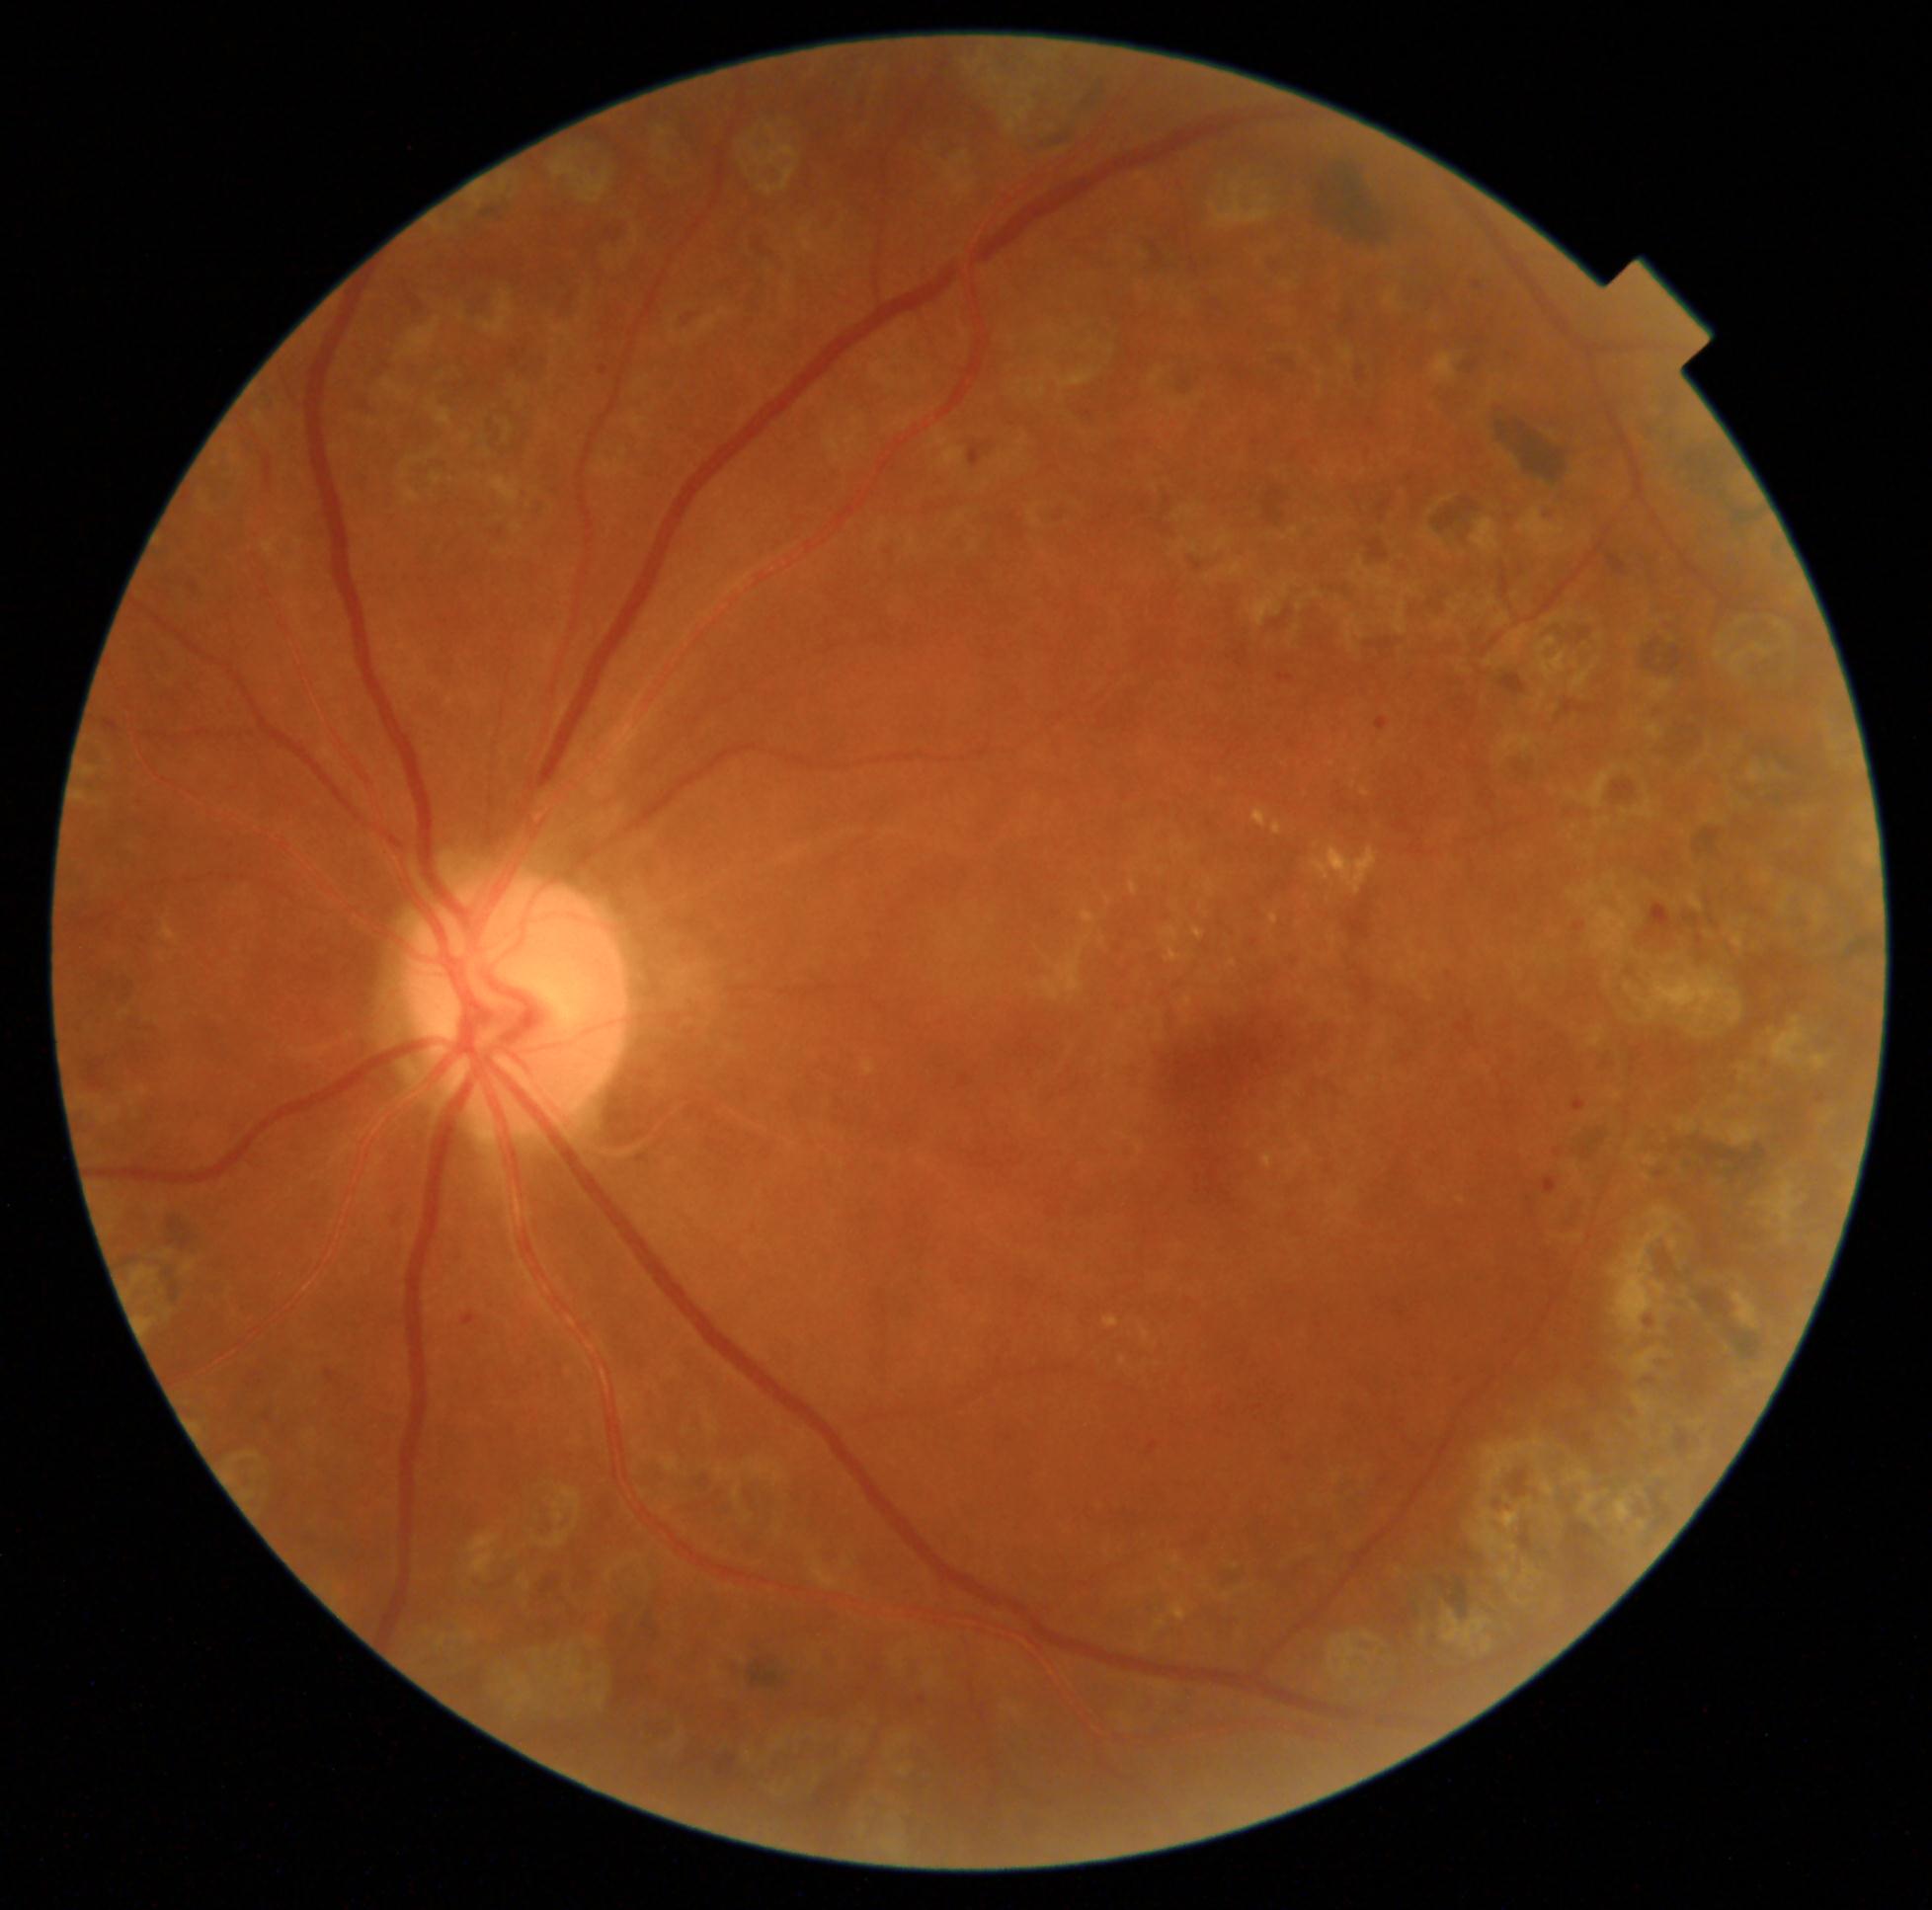 • DR class: non-proliferative diabetic retinopathy
• DR stage: 2/4